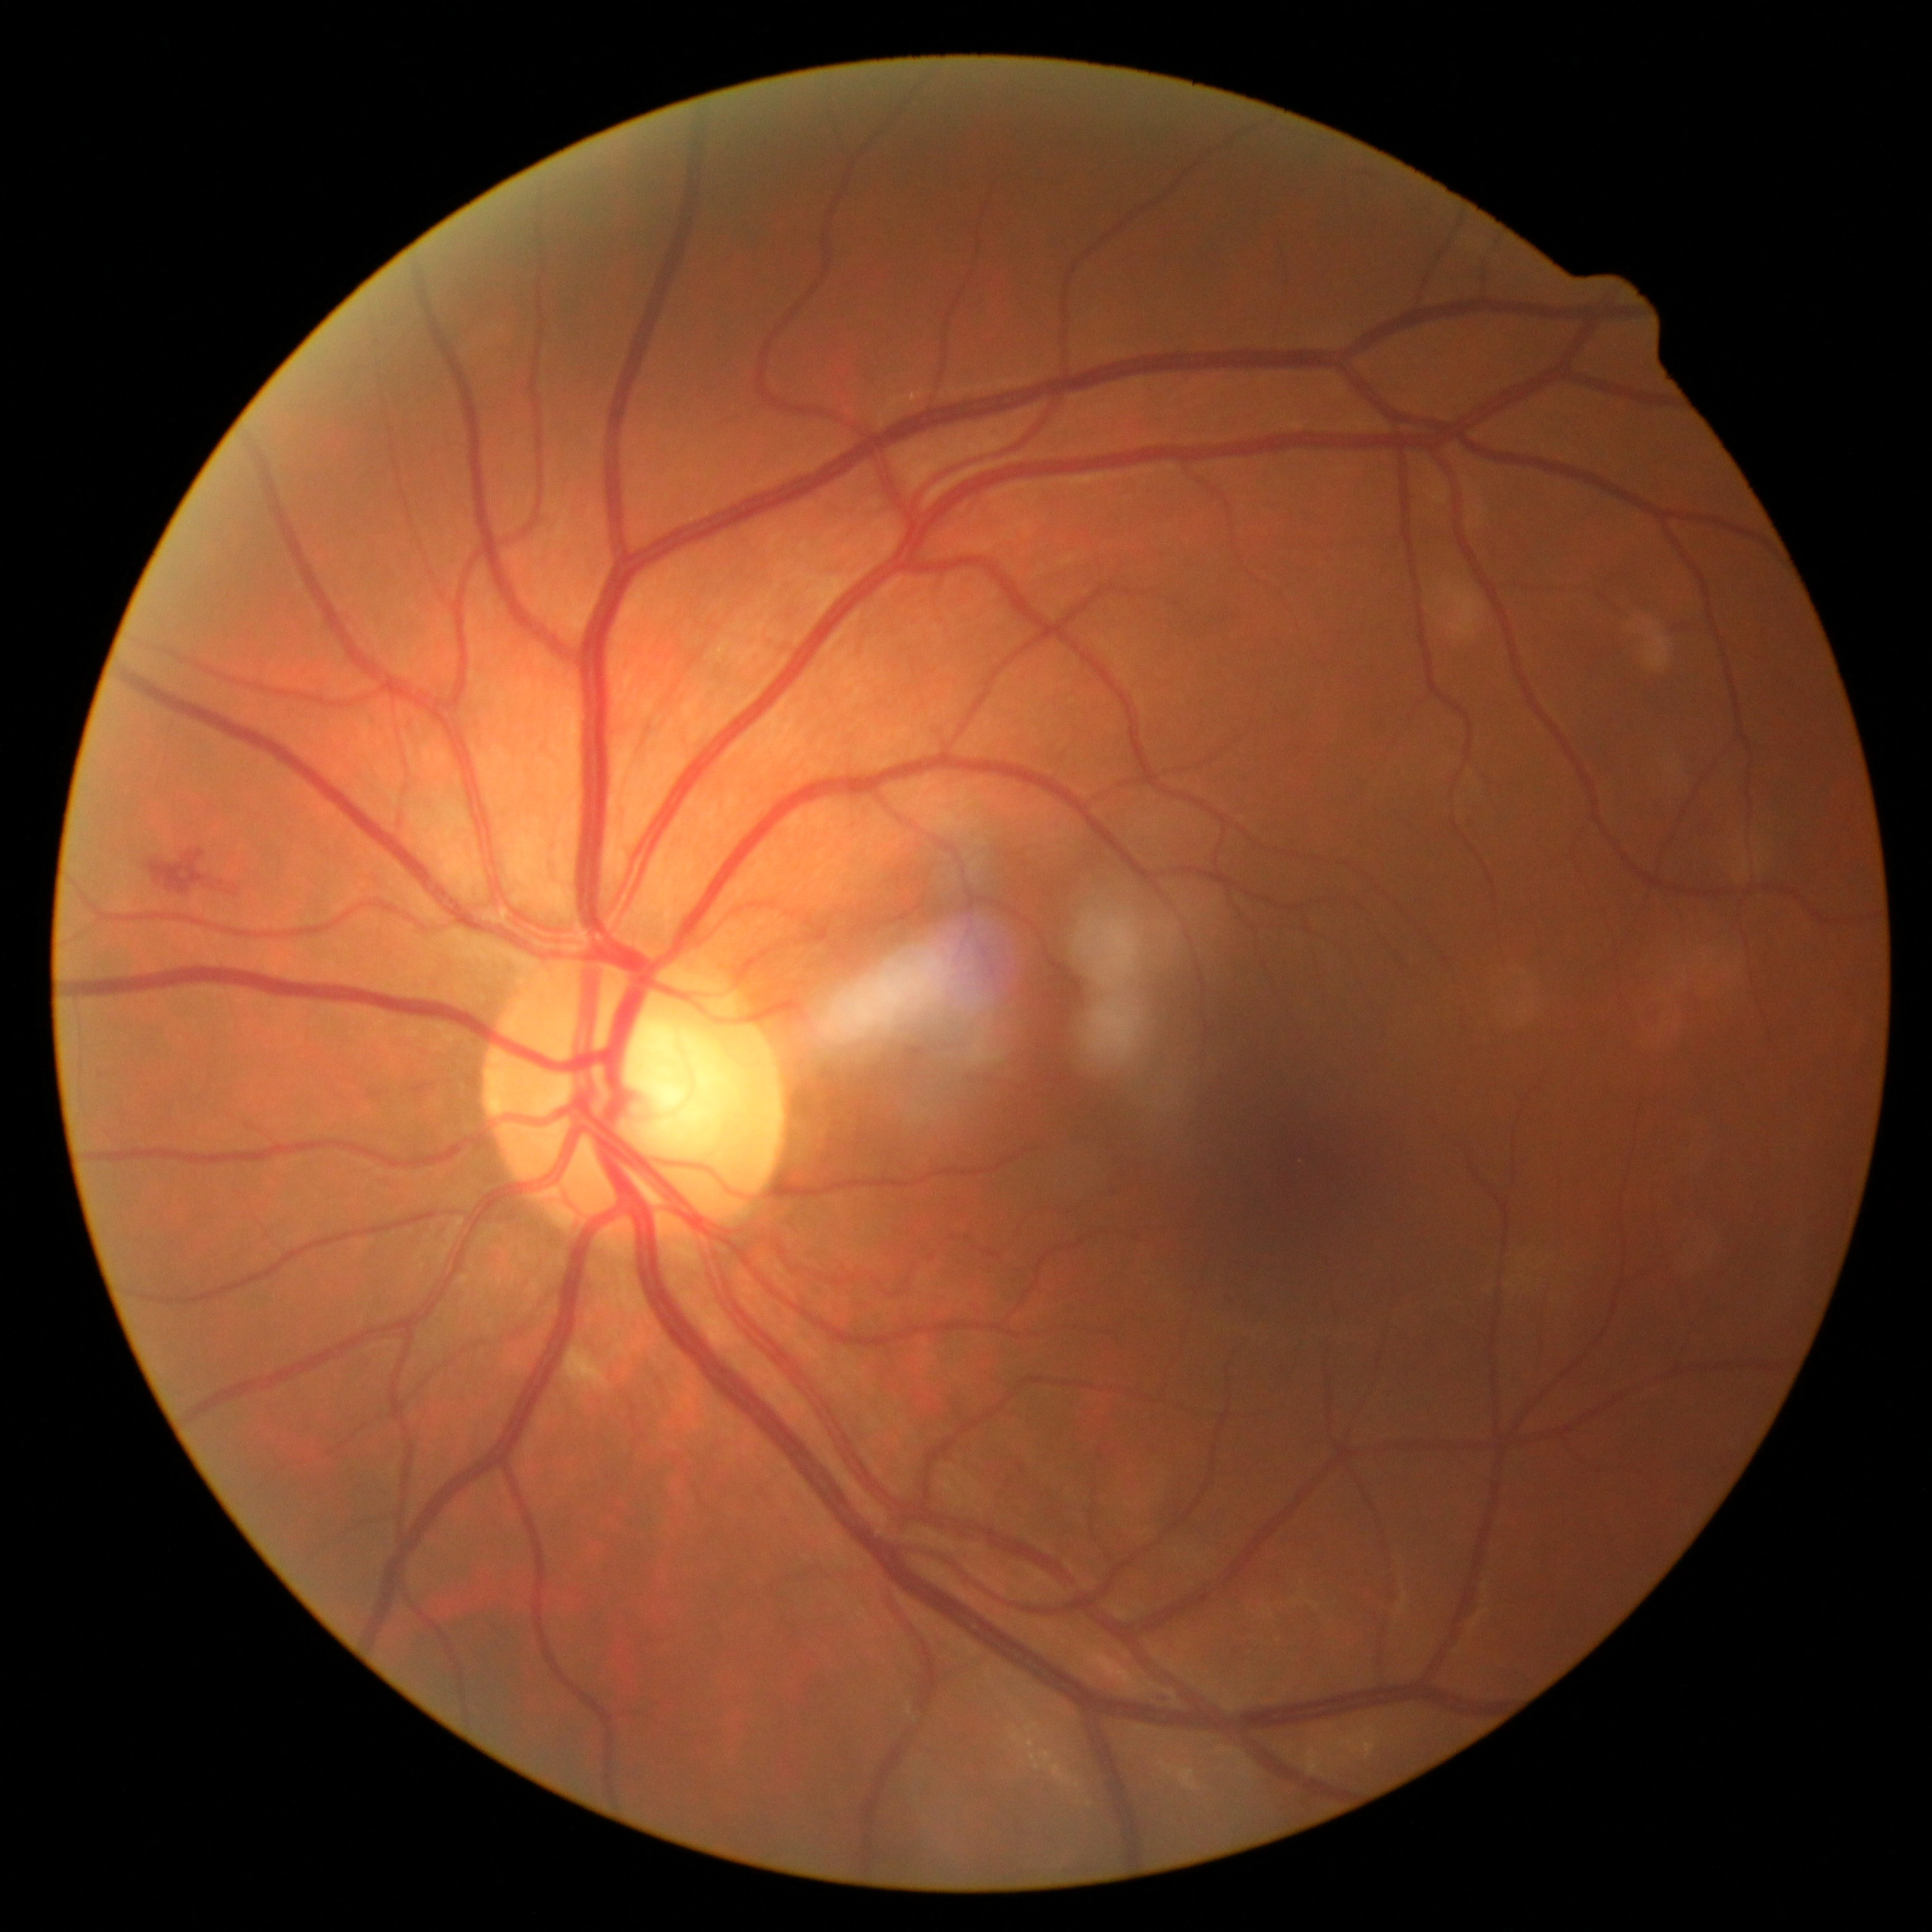

Diabetic retinopathy (DR) is 2/4.